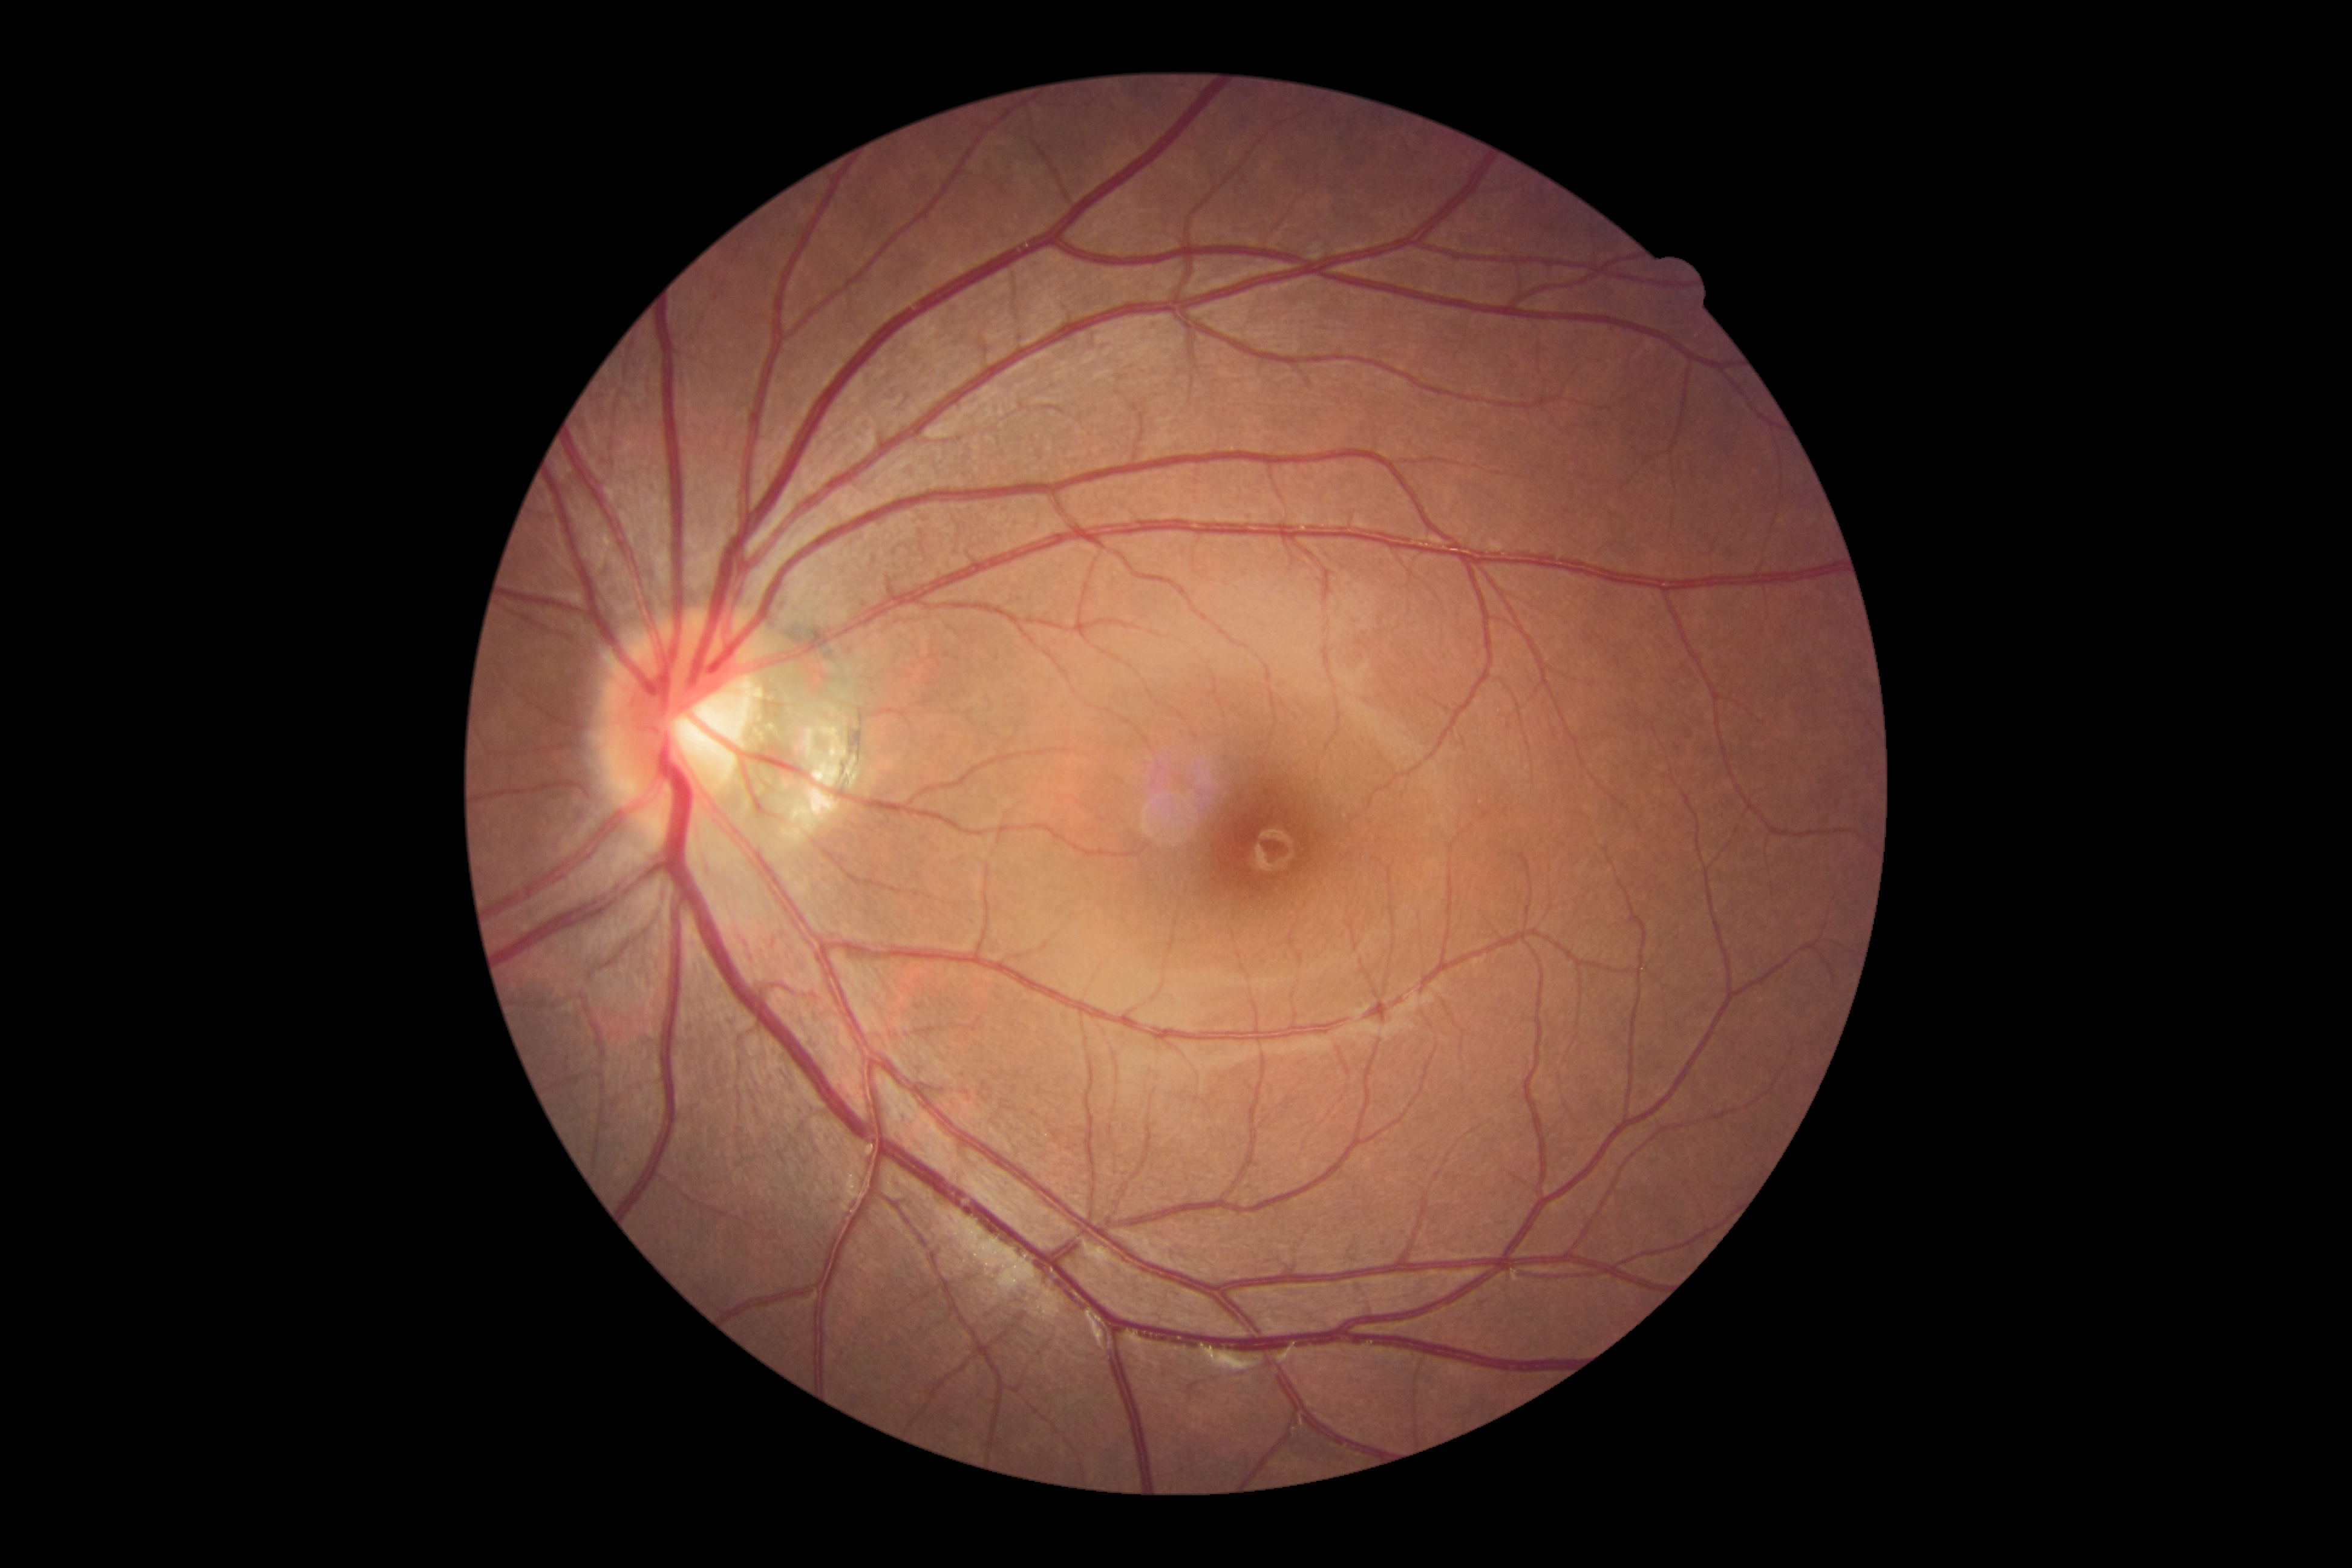 diabetic retinopathy (DR): 0 — no visible signs of diabetic retinopathy.